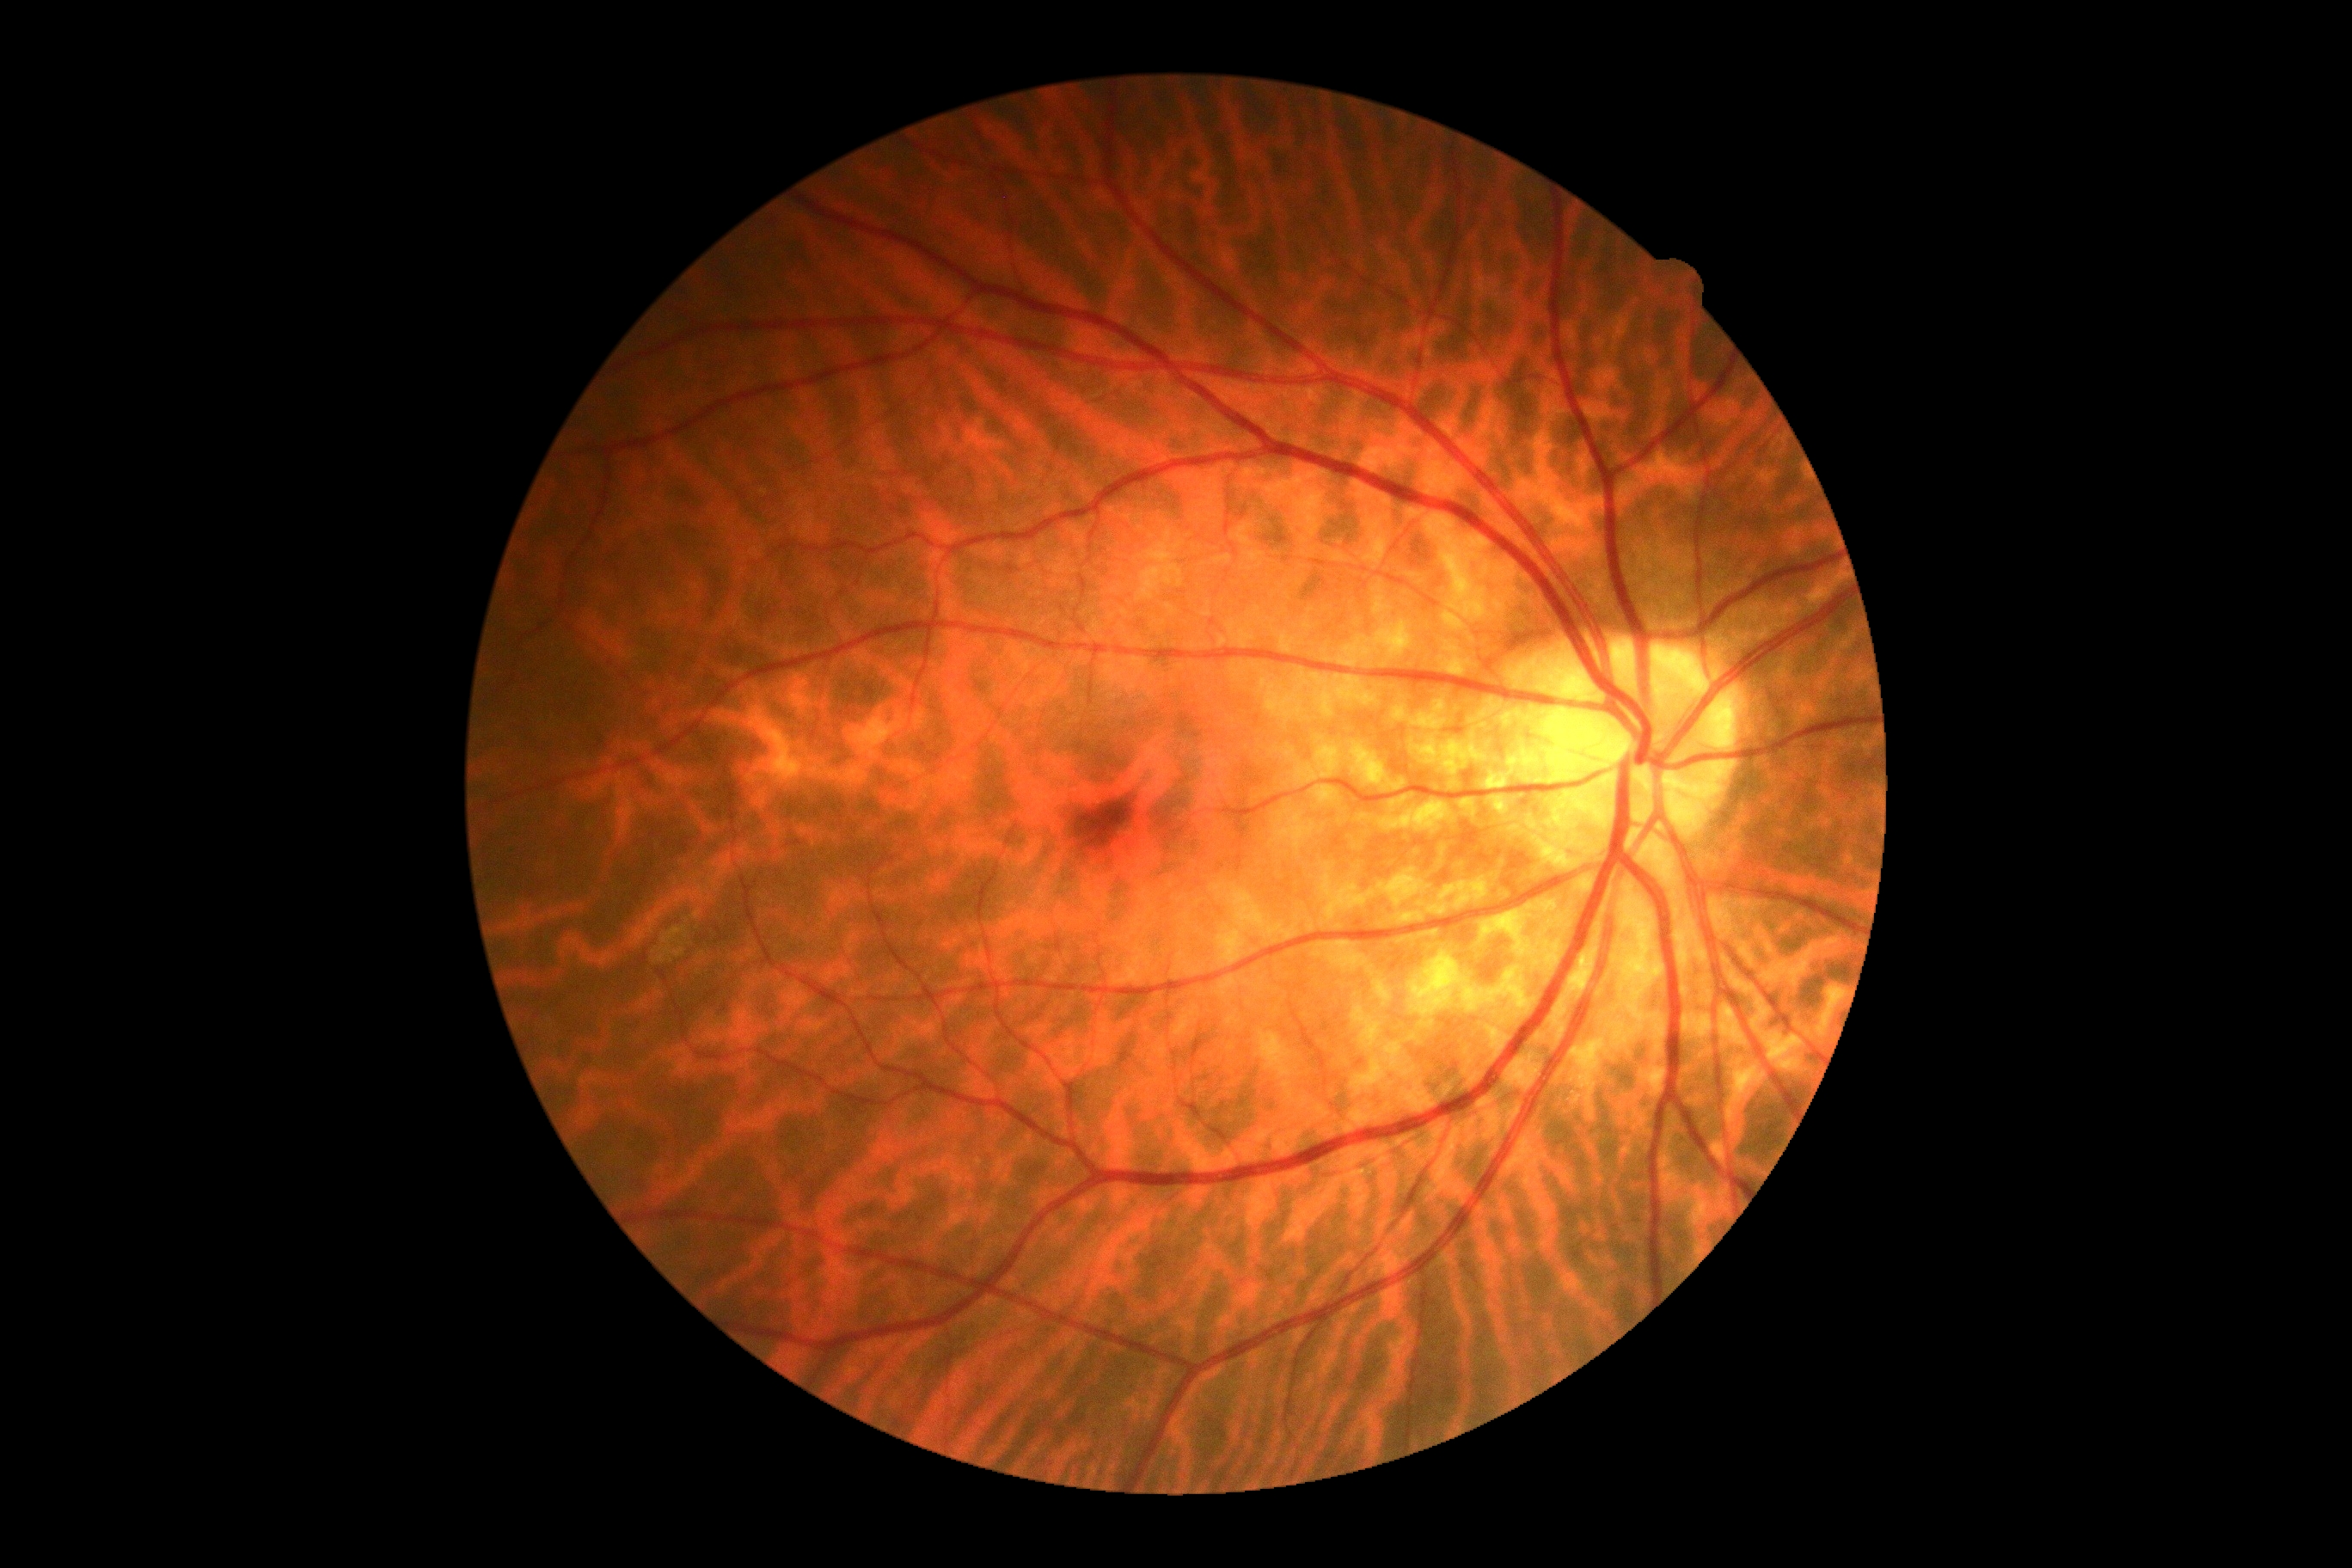

  dr_grade: 0/4